DR severity per modified Davis staging · FOV: 45 degrees · no pharmacologic dilation: 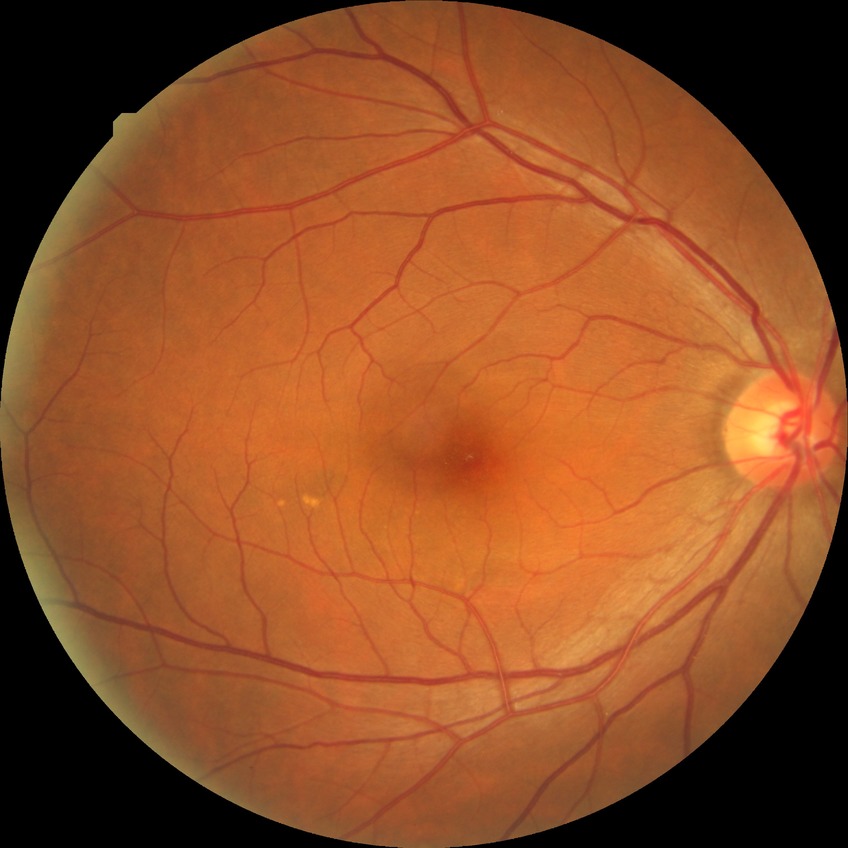

  davis_grade: NDR (no diabetic retinopathy)